Camera: NIDEK AFC-230:
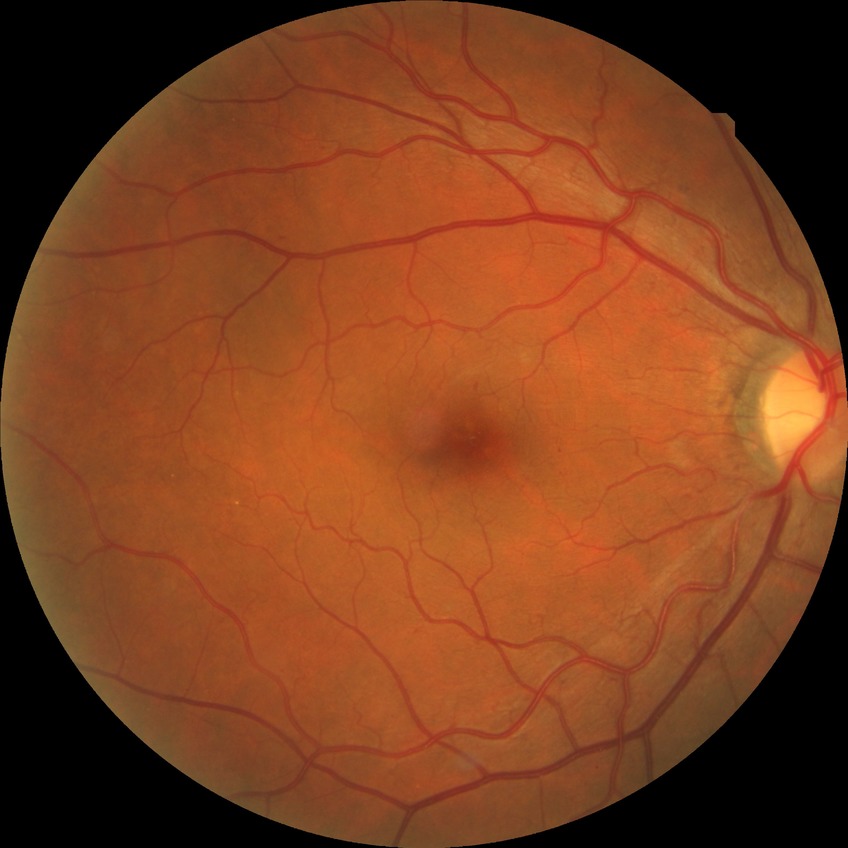

DR severity: SDR.